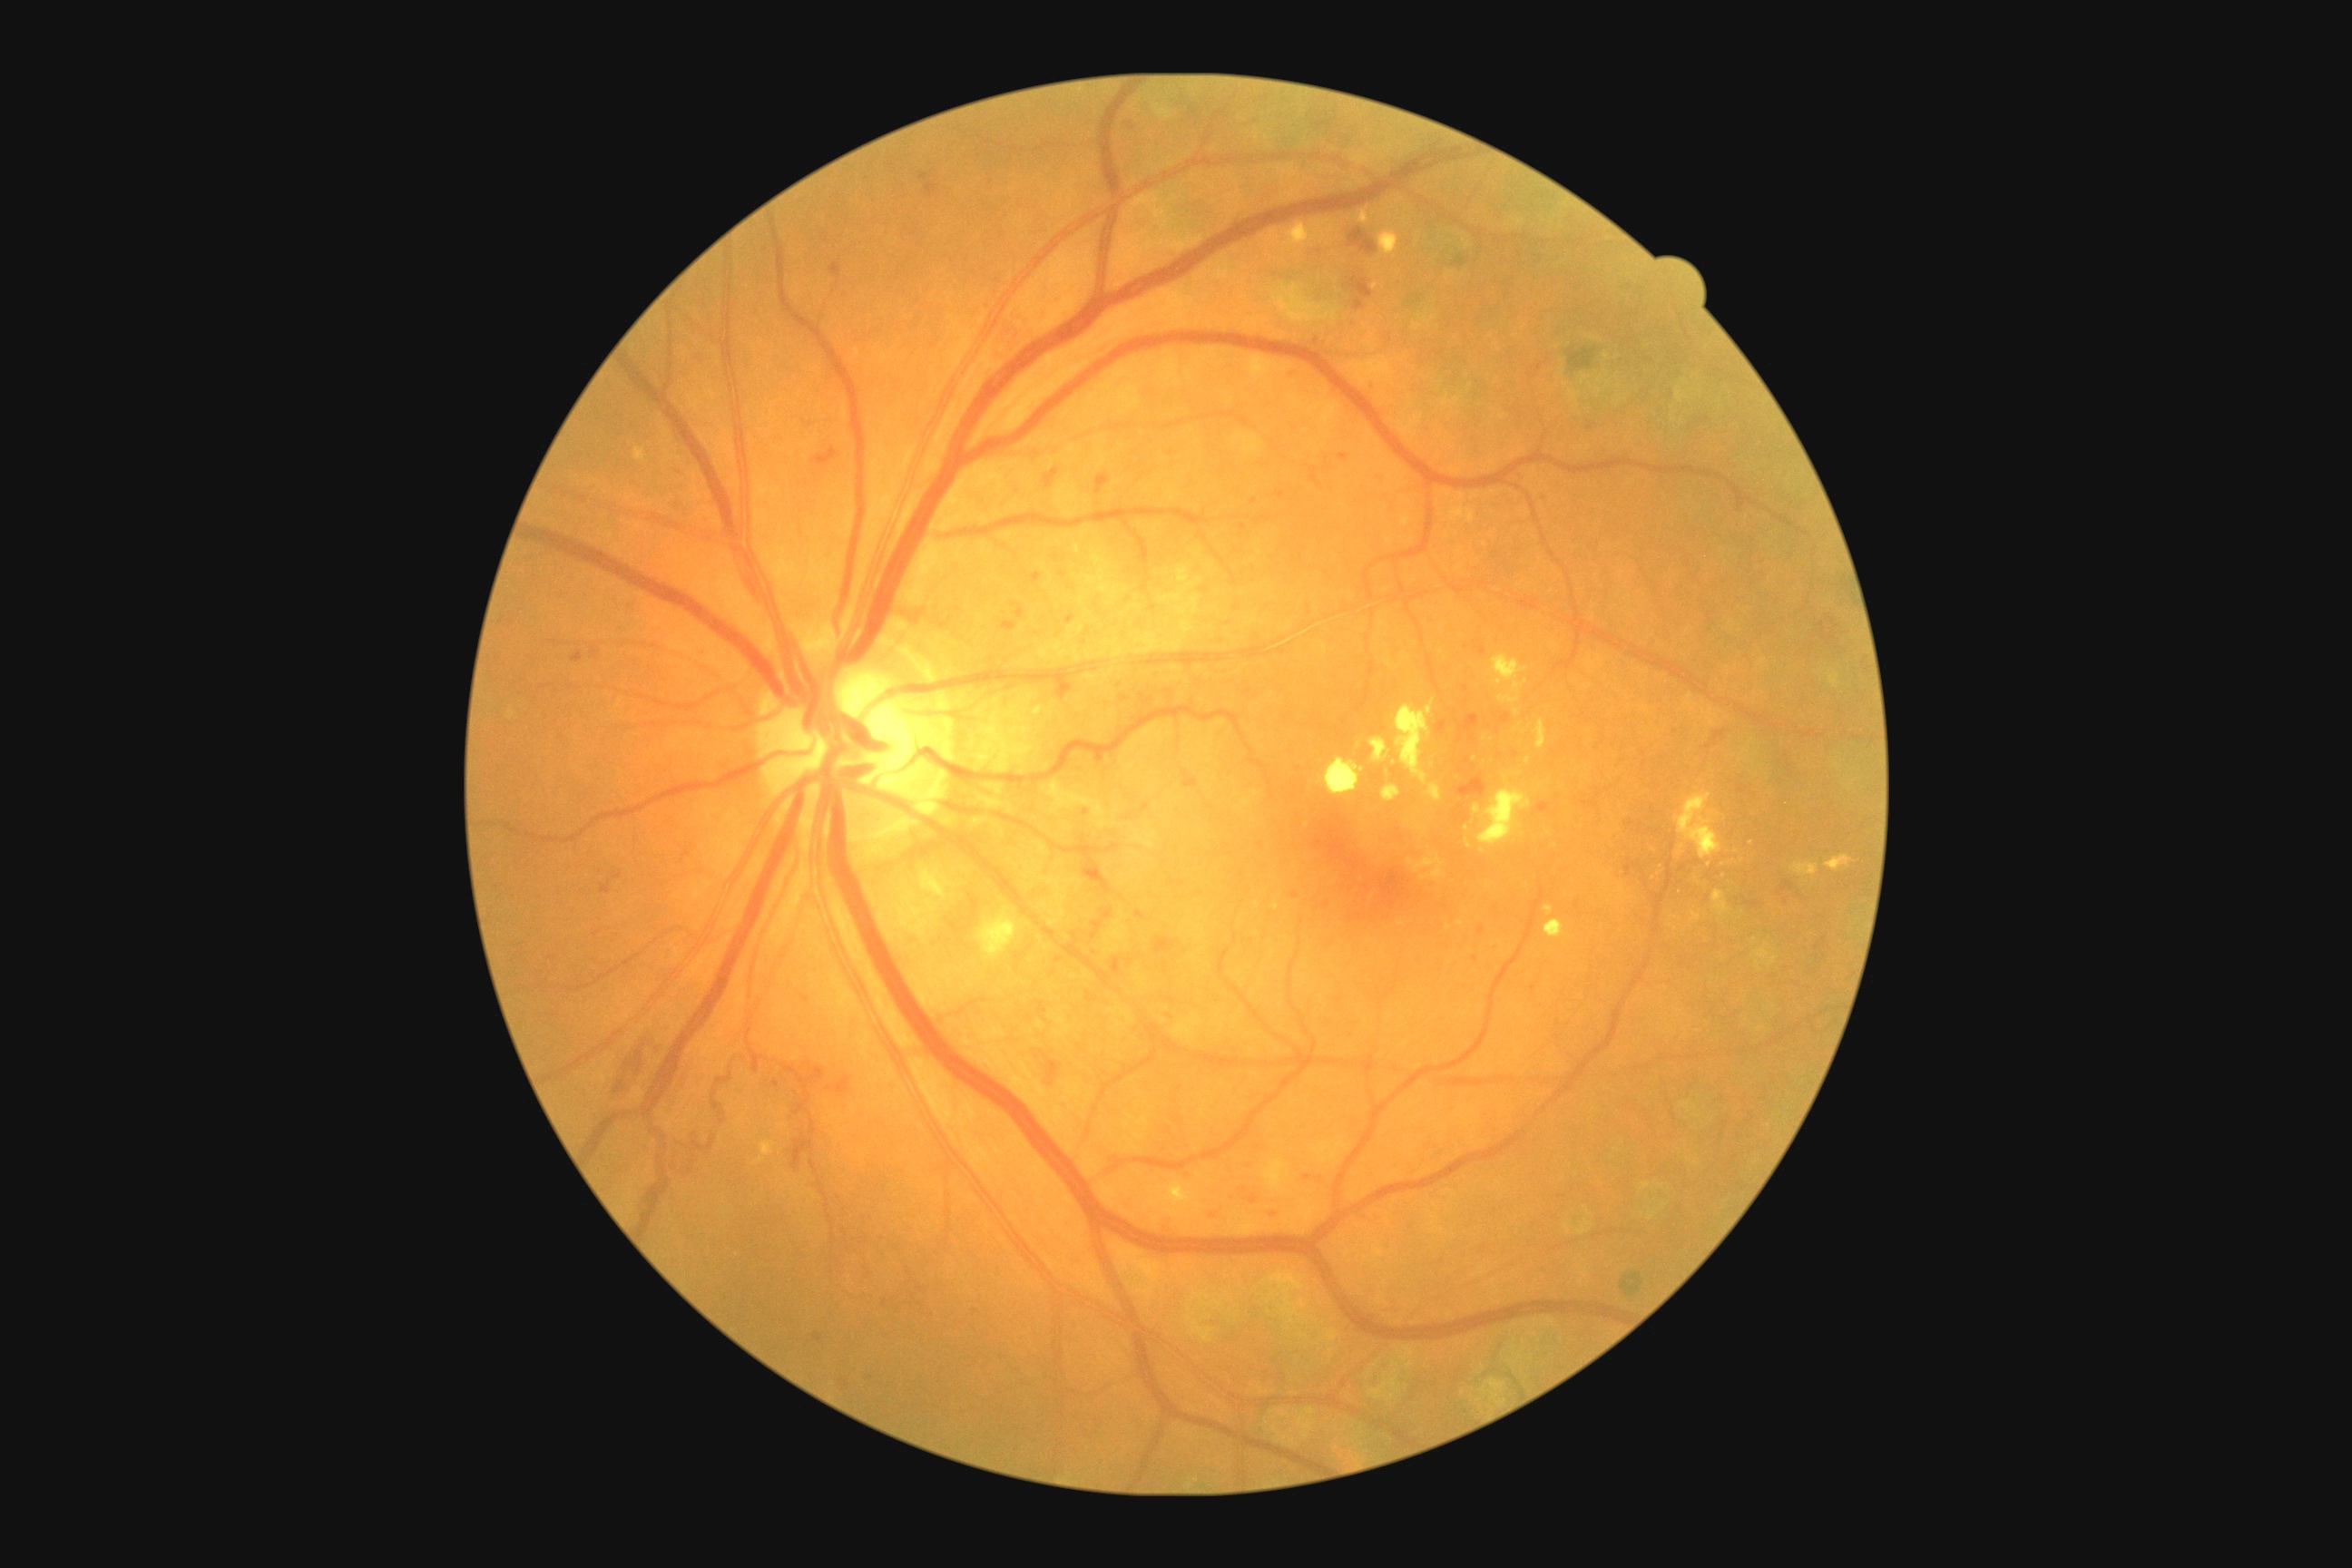 partial: true
dr_grade: 3
lesions:
  ex:
    - {"left": 1155, "top": 1186, "right": 1170, "bottom": 1199}
    - {"left": 1493, "top": 654, "right": 1529, "bottom": 705}
    - {"left": 1545, "top": 921, "right": 1565, "bottom": 939}
    - {"left": 1371, "top": 738, "right": 1391, "bottom": 763}
    - {"left": 1545, "top": 906, "right": 1553, "bottom": 916}
    - {"left": 1692, "top": 912, "right": 1701, "bottom": 921}
    - {"left": 761, "top": 1142, "right": 776, "bottom": 1157}
    - {"left": 1396, "top": 700, "right": 1435, "bottom": 785}
    - {"left": 1792, "top": 863, "right": 1819, "bottom": 877}
  ex_small:
    - 1710, 865
    - 1394, 763
    - 1520, 774
    - 1507, 778
    - 759, 1161
    - 1475, 758
  he:
    - {"left": 1738, "top": 783, "right": 1749, "bottom": 794}
    - {"left": 1142, "top": 805, "right": 1150, "bottom": 812}
    - {"left": 1179, "top": 1171, "right": 1191, "bottom": 1184}
    - {"left": 591, "top": 649, "right": 600, "bottom": 656}
    - {"left": 1266, "top": 1210, "right": 1280, "bottom": 1222}
    - {"left": 1536, "top": 493, "right": 1553, "bottom": 505}
    - {"left": 1202, "top": 1208, "right": 1220, "bottom": 1222}
    - {"left": 1514, "top": 471, "right": 1525, "bottom": 480}
    - {"left": 1039, "top": 1057, "right": 1063, "bottom": 1086}
    - {"left": 1044, "top": 467, "right": 1059, "bottom": 489}
    - {"left": 803, "top": 422, "right": 812, "bottom": 426}
    - {"left": 1458, "top": 714, "right": 1480, "bottom": 734}
    - {"left": 805, "top": 1063, "right": 856, "bottom": 1095}
    - {"left": 1081, "top": 805, "right": 1092, "bottom": 819}
    - {"left": 925, "top": 182, "right": 936, "bottom": 195}
  he_small:
    - 1129, 125
    - 1786, 903
    - 1474, 767